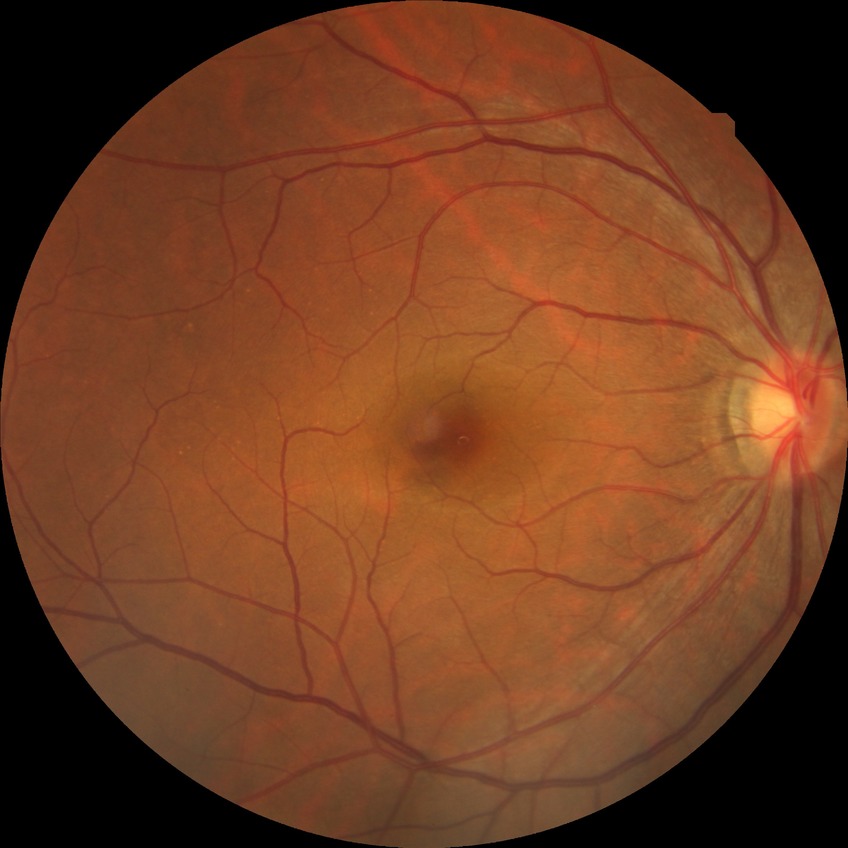

retinopathy grade=no diabetic retinopathy.